Fundus photo · image size 412x310: 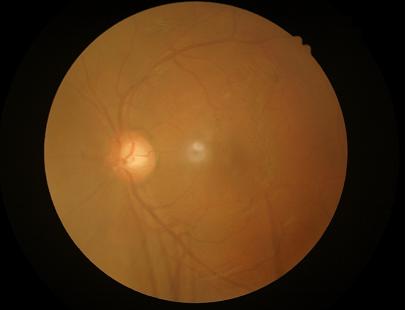
{"clarity": "out of focus", "overall_quality": "poor", "contrast": "good", "illumination": "poor"}